Color fundus photograph:
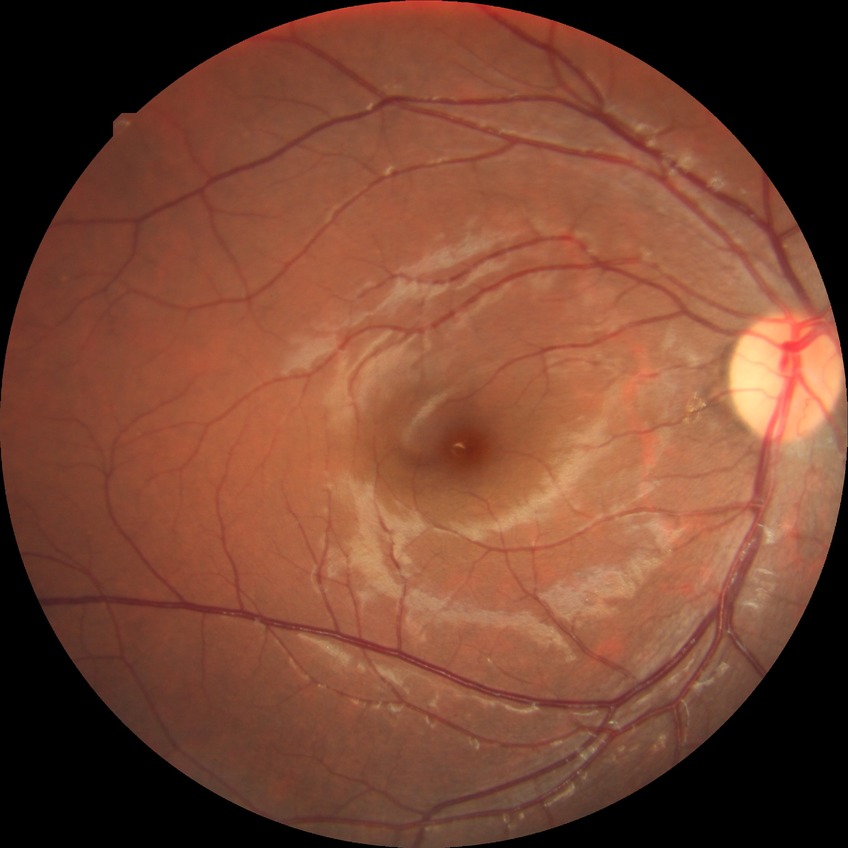

diabetic retinopathy (DR)@NDR (no diabetic retinopathy).